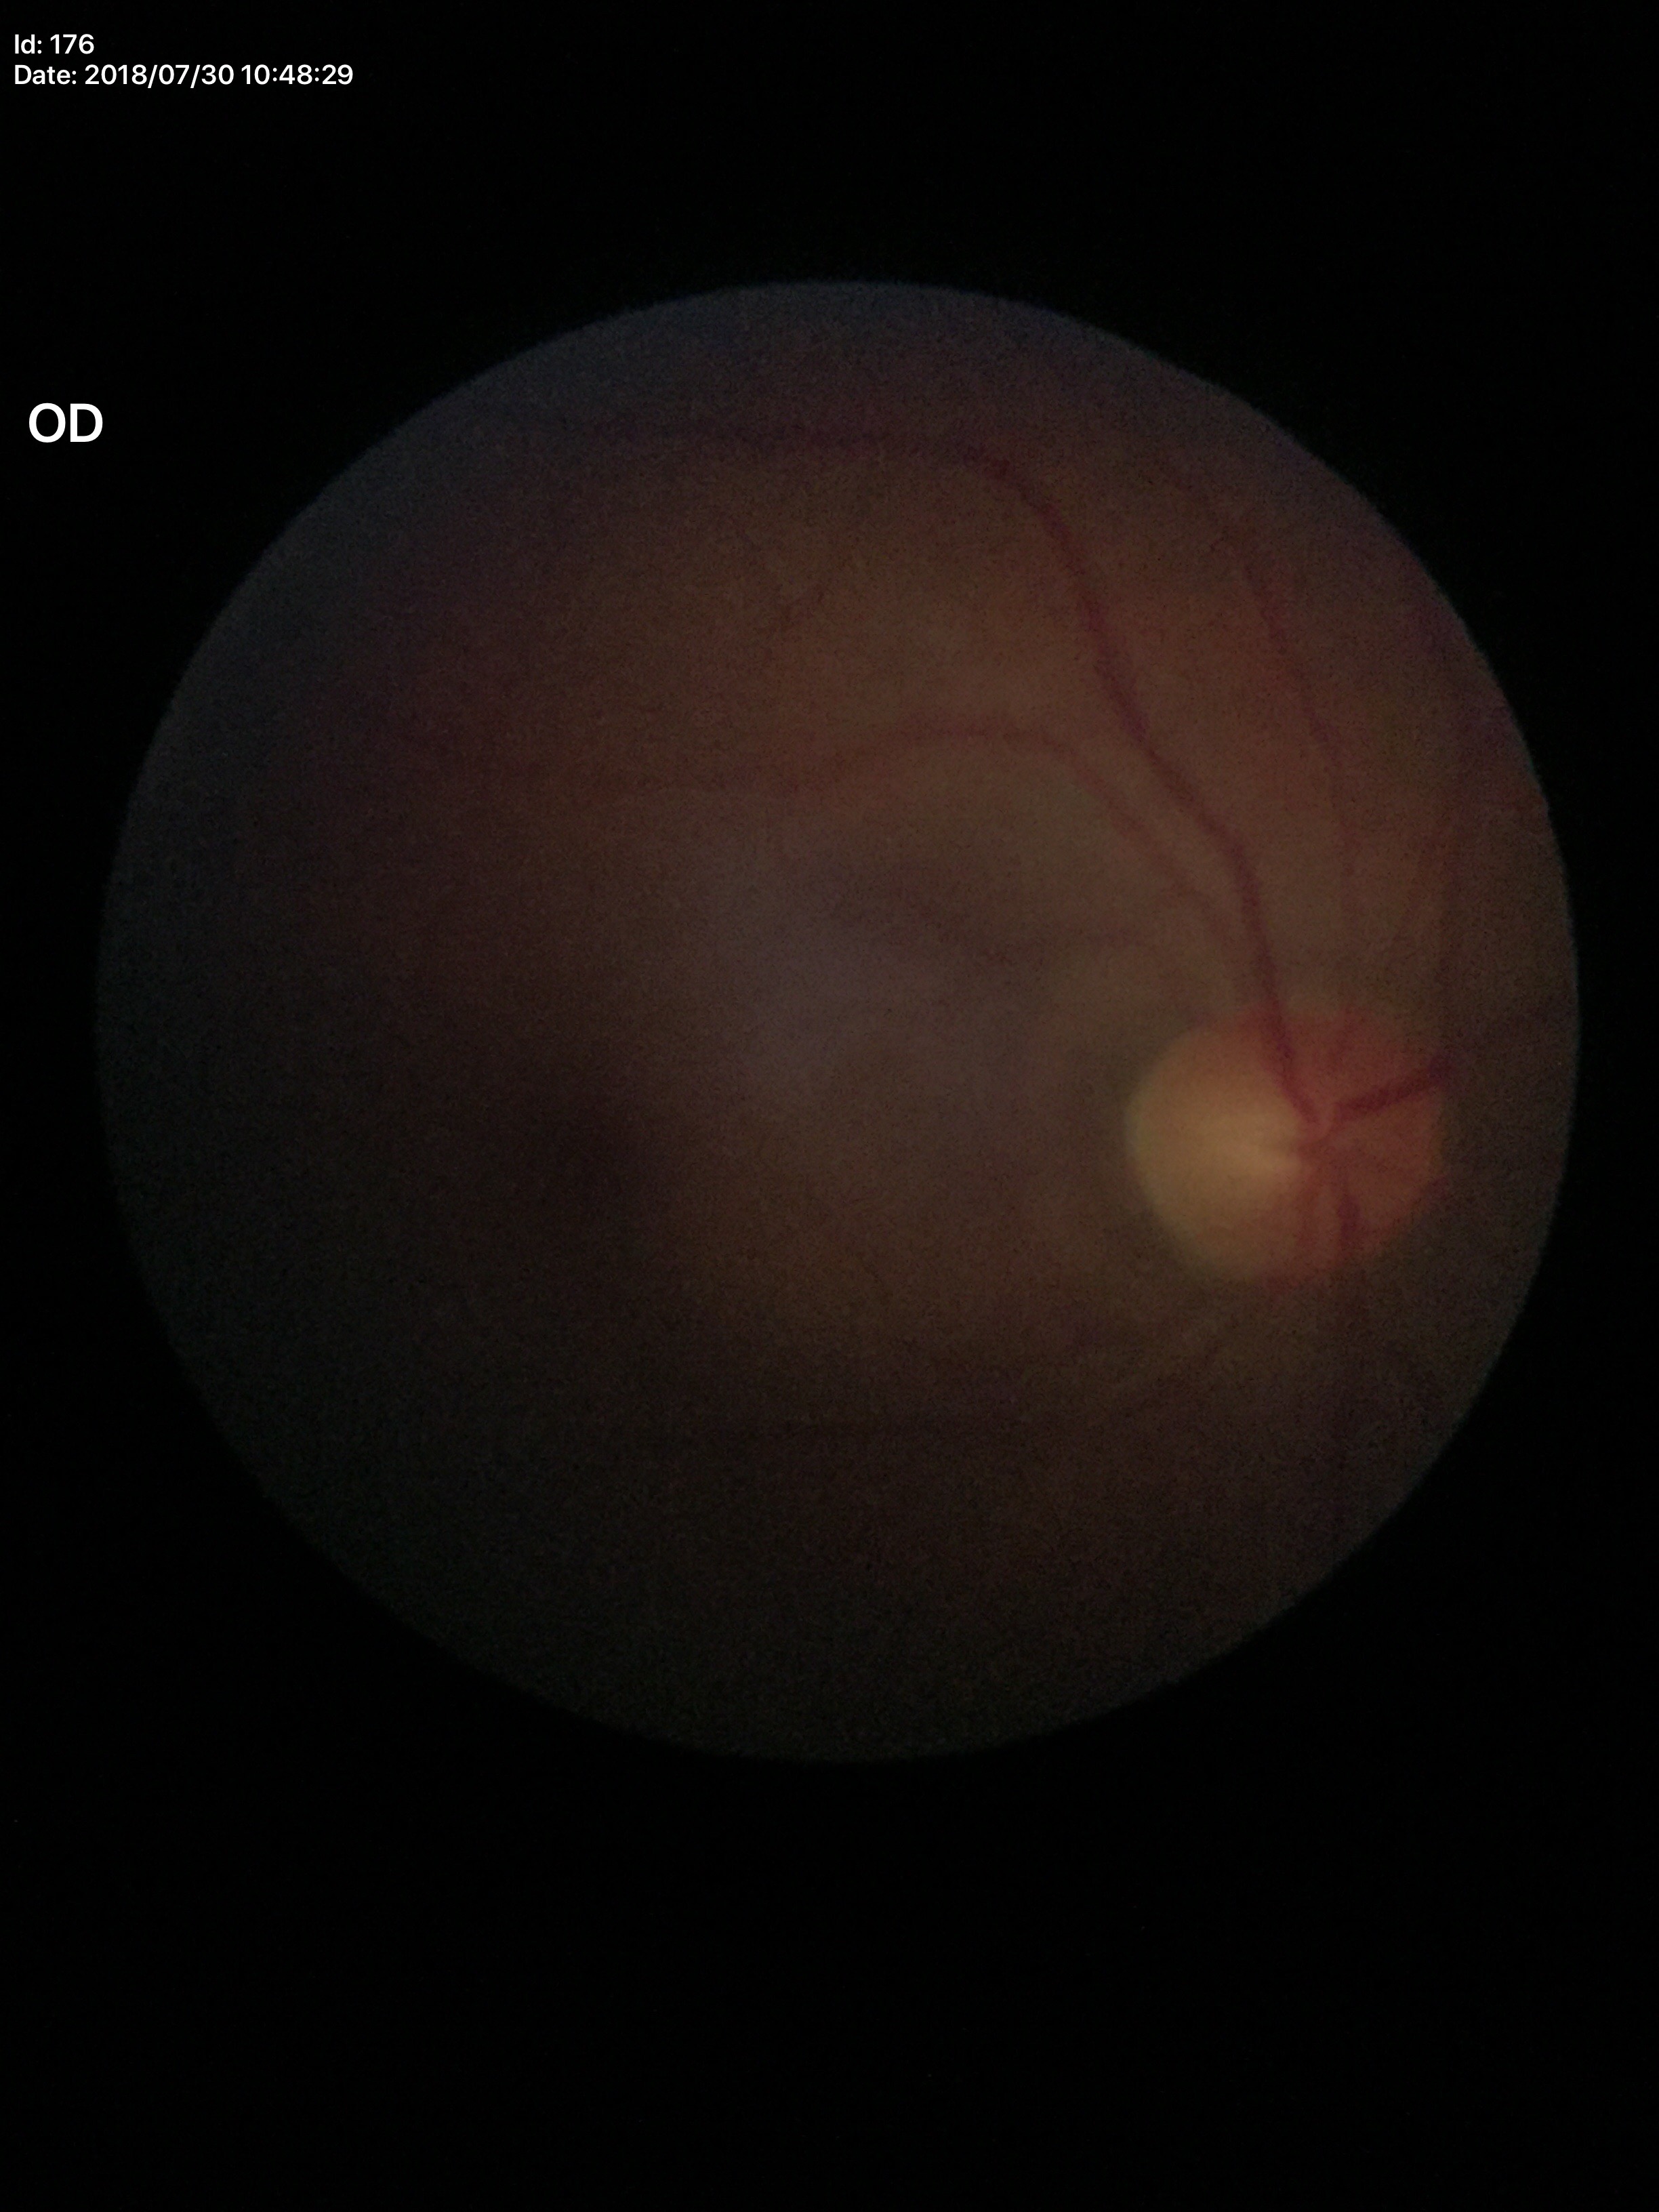

VCDR is 0.42. No glaucomatous optic neuropathy. HCDR: 0.47.